2352 by 1568 pixels:
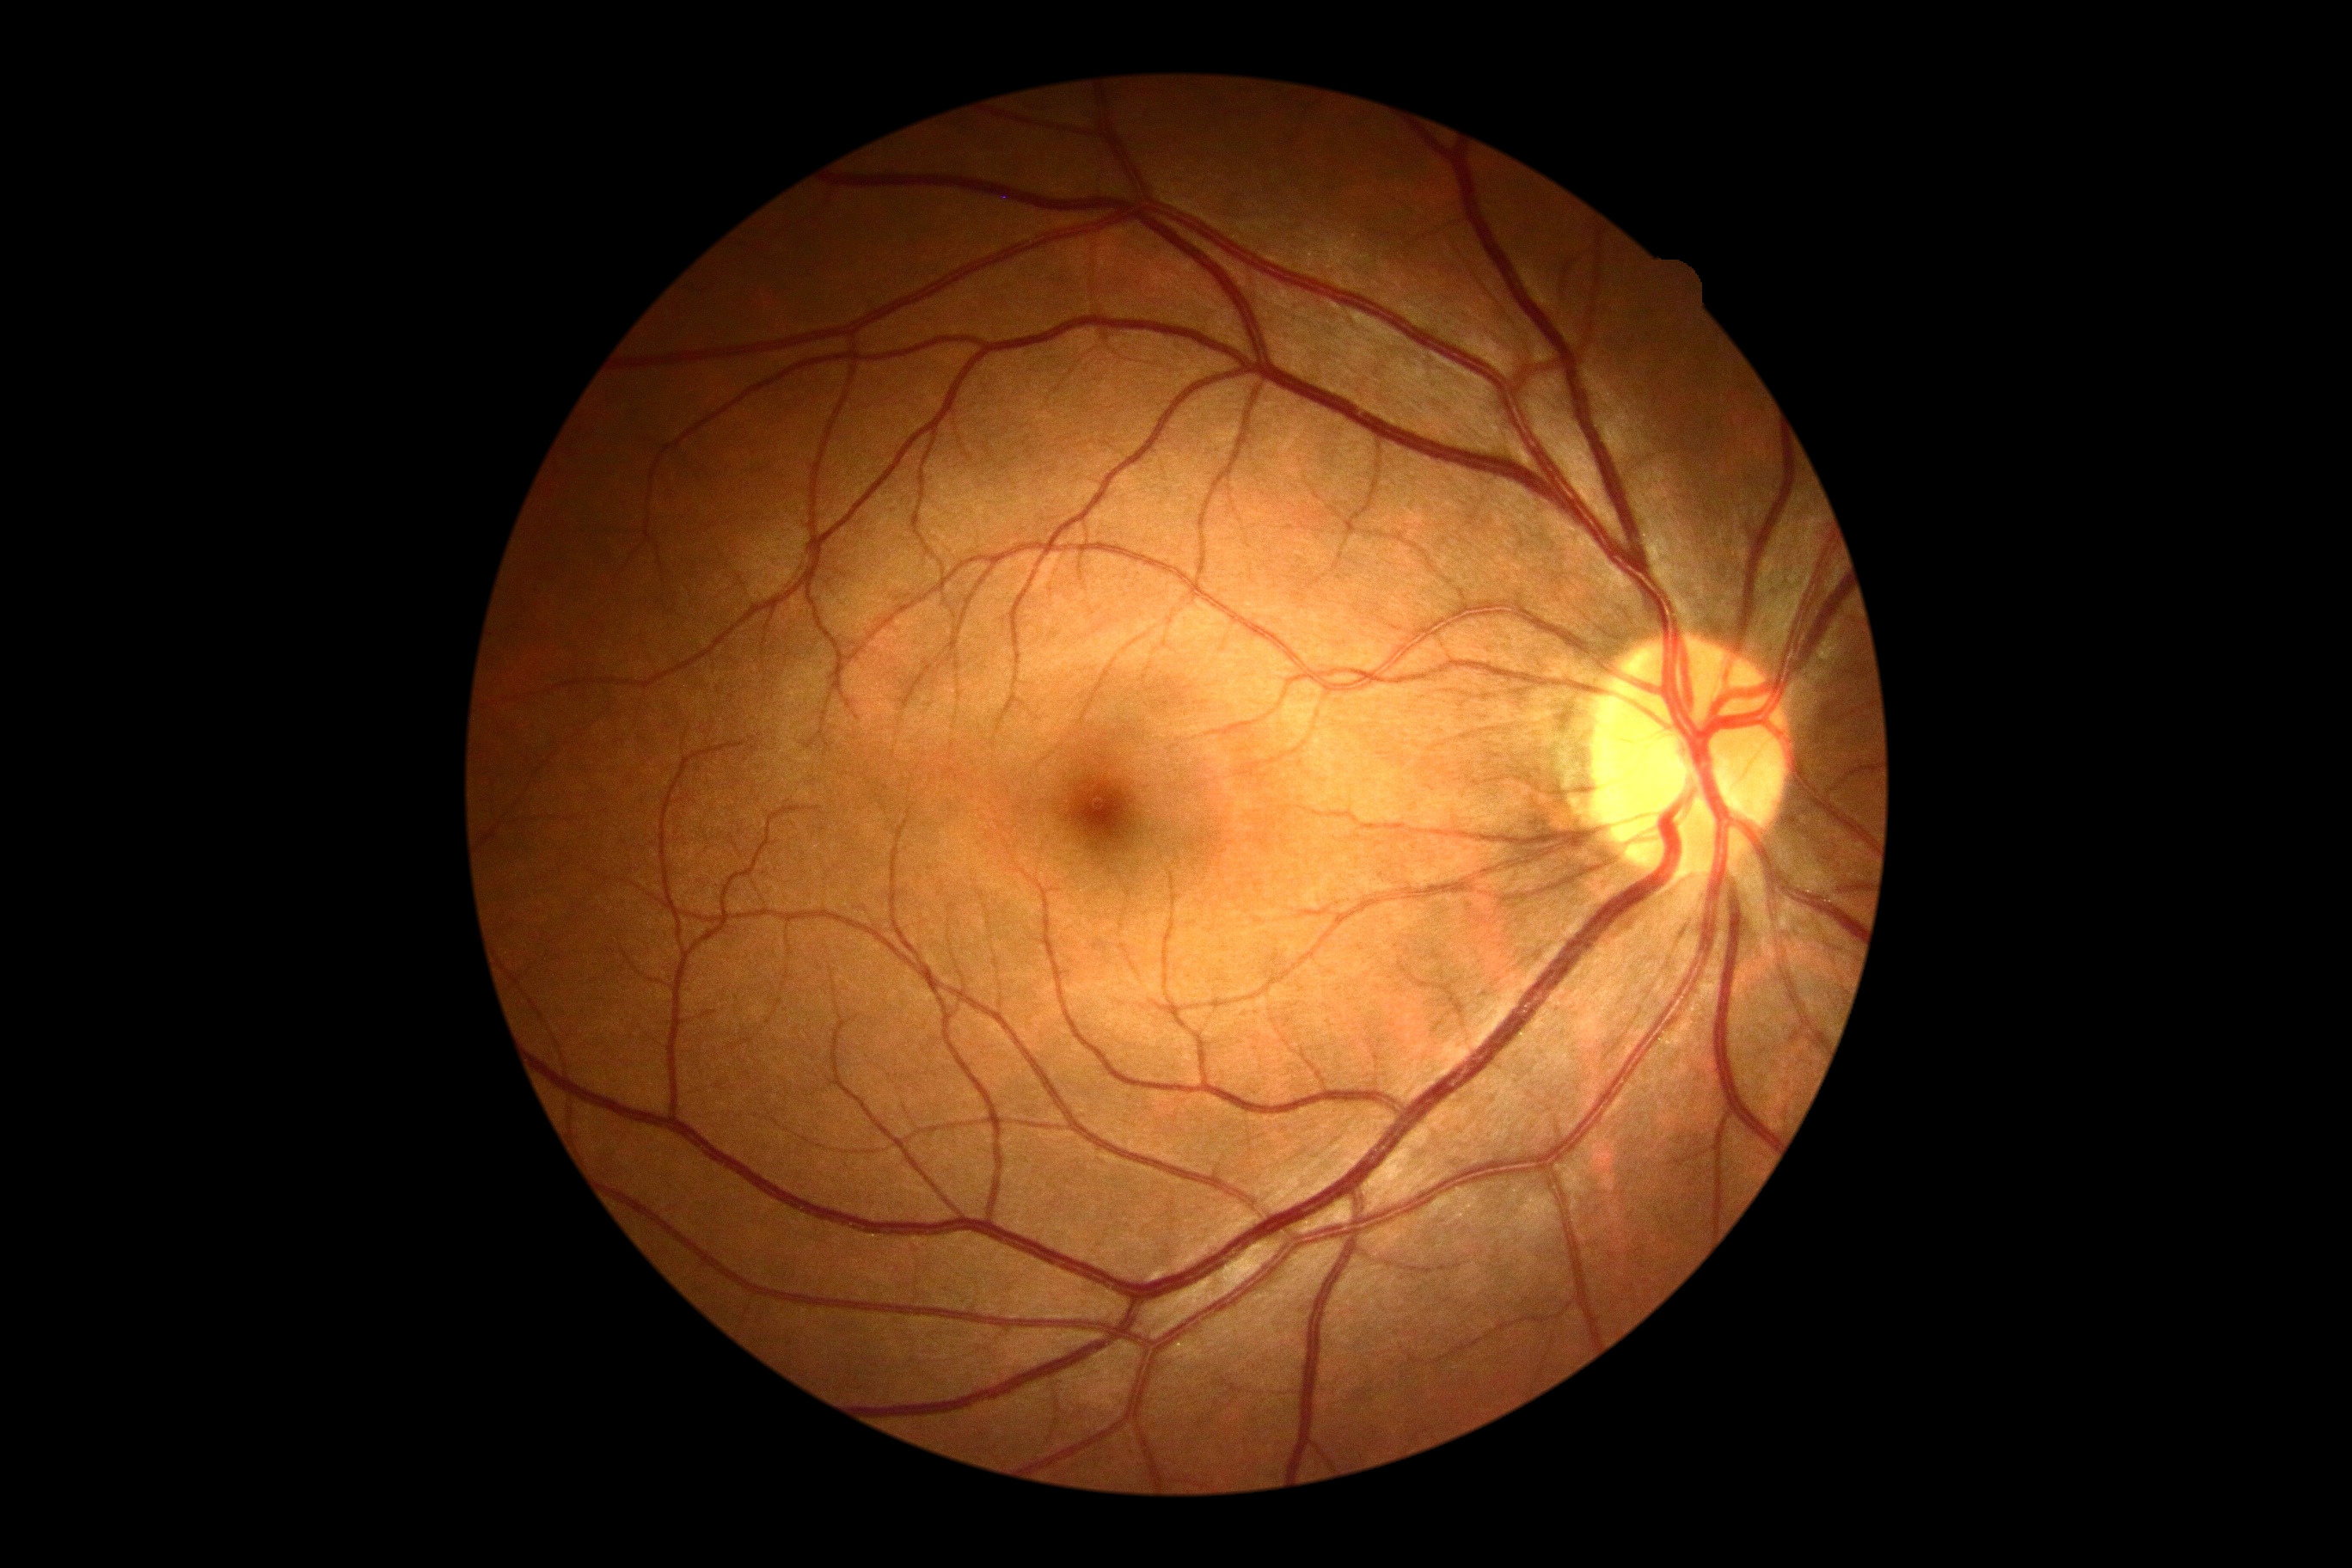 Diabetic retinopathy (DR) is grade 0 (no apparent retinopathy).
No signs of diabetic retinopathy.